Axial length: 23.85 mm · gender: M · autorefraction: sphere +0.5 D, cylinder -0.5 D, axis 7° · retinal fundus photograph:
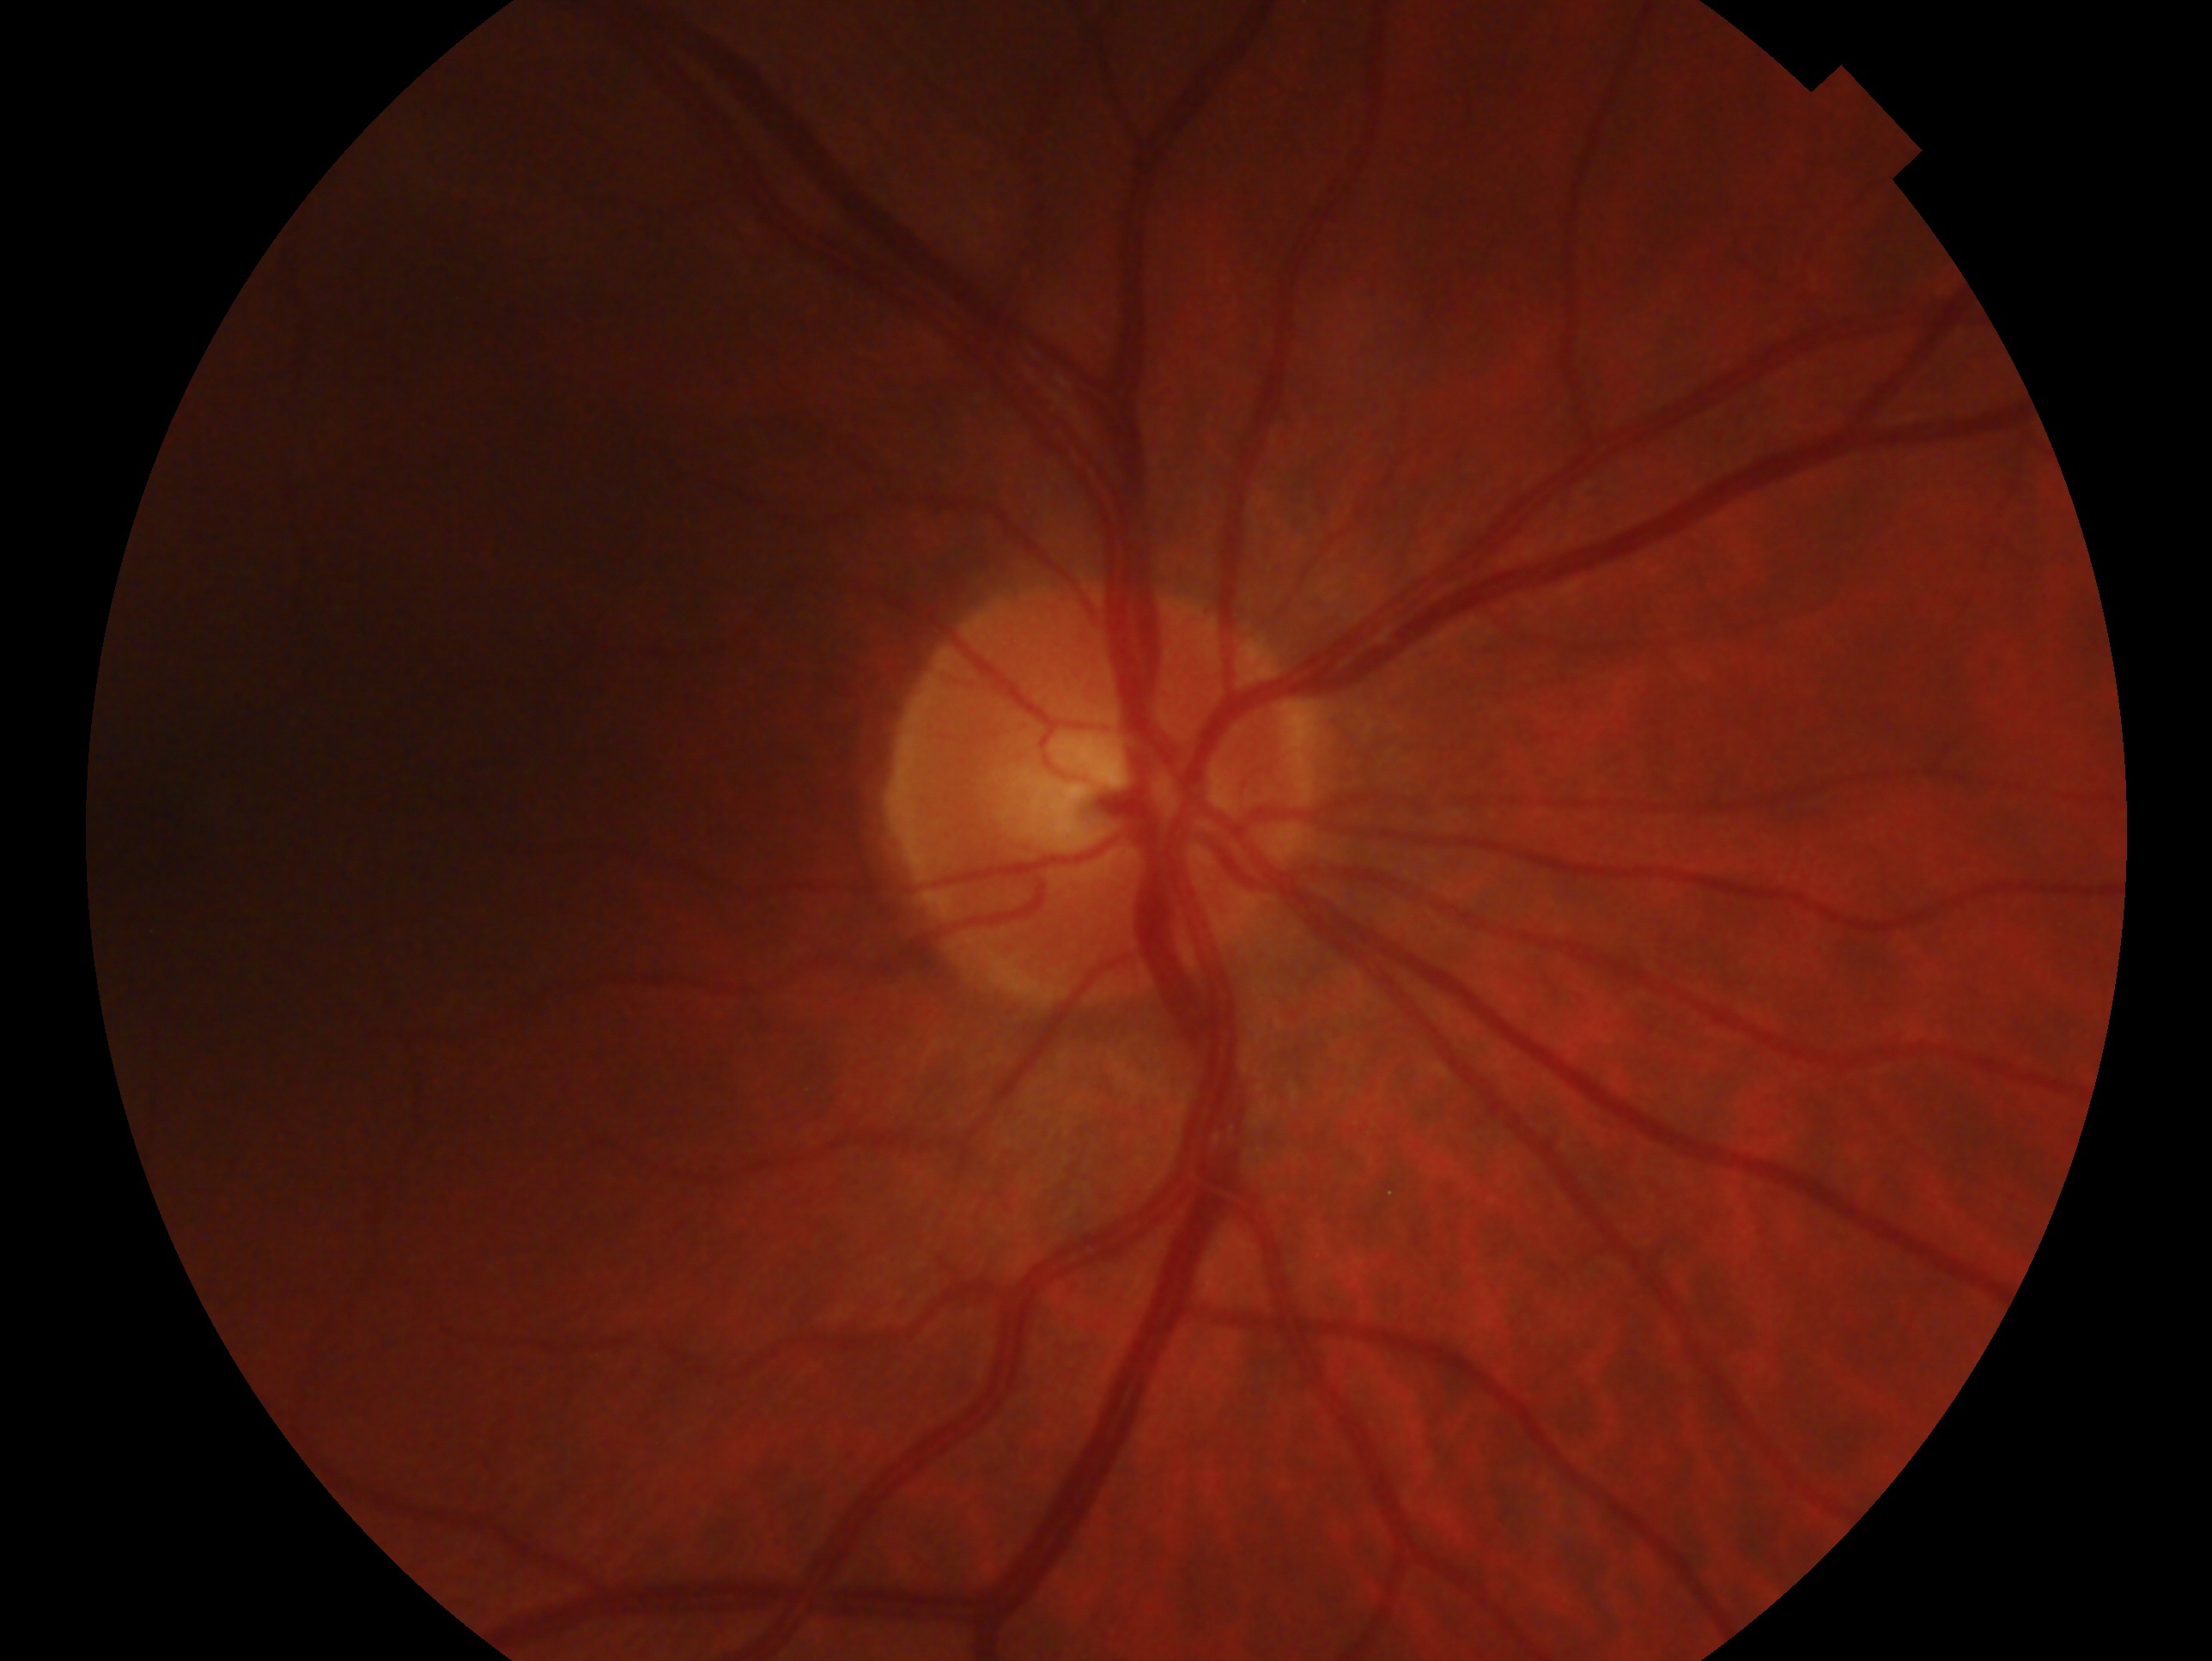 Annotations:
– laterality: right eye
– clinical classification: no glaucomatous findings